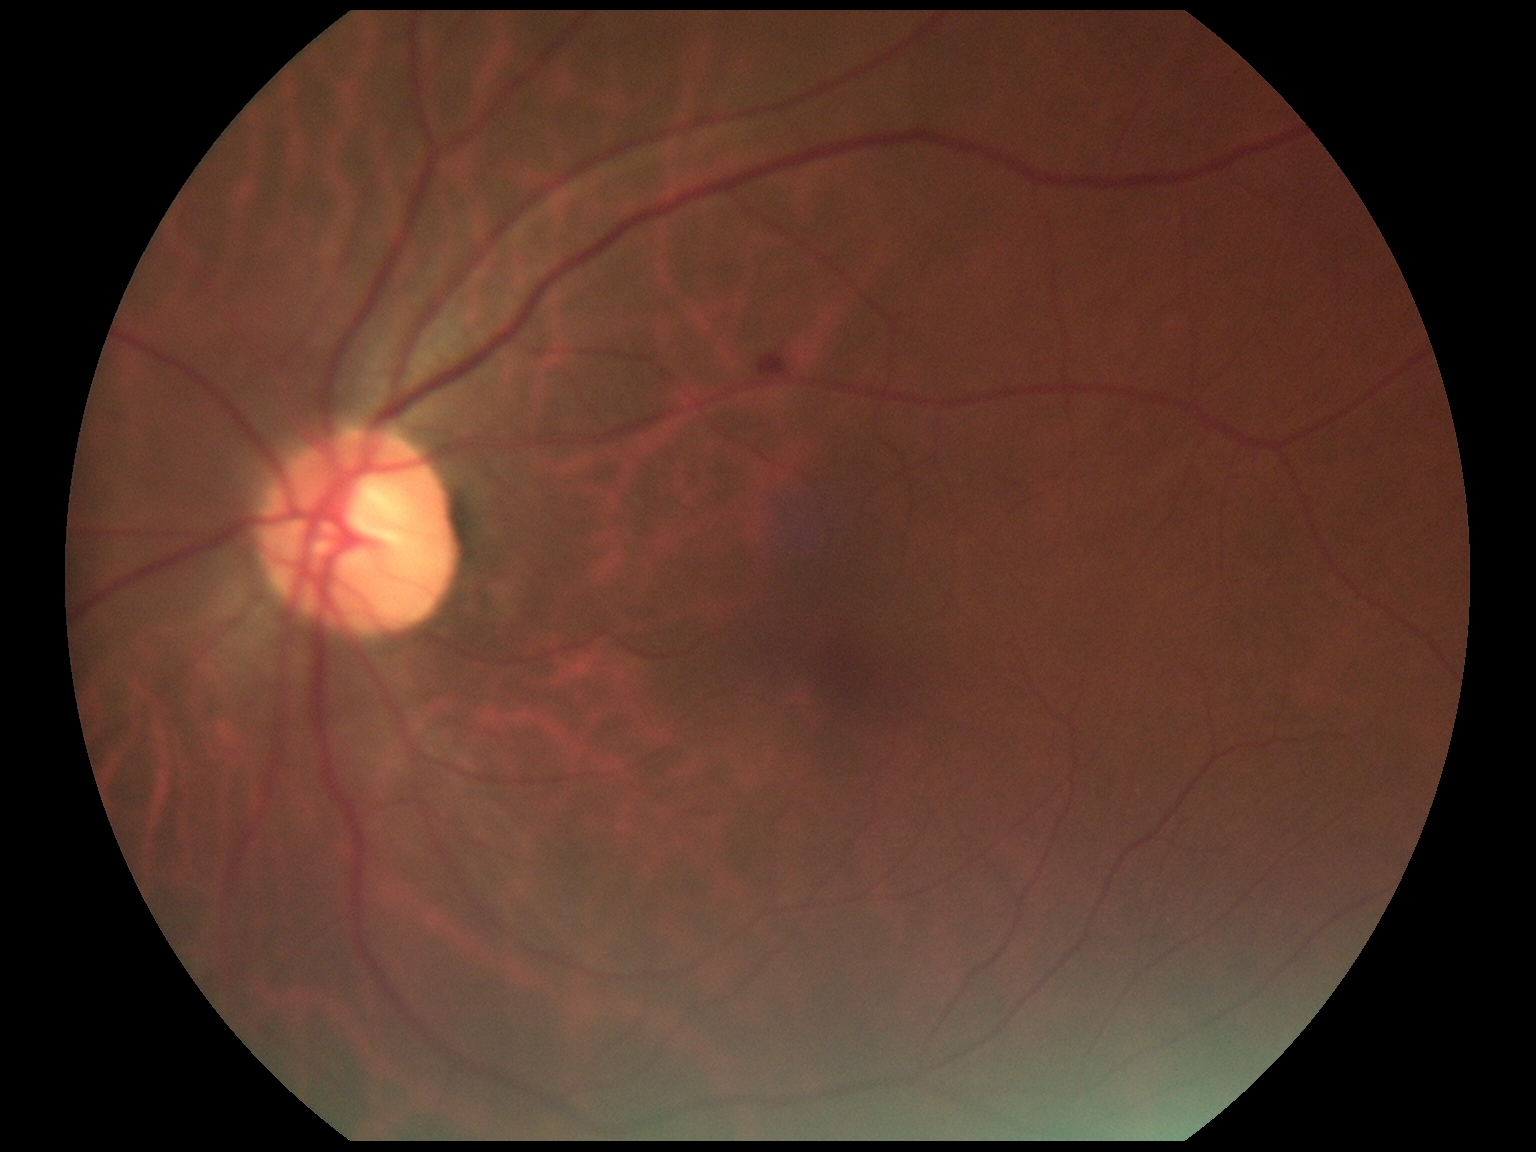 Retinopathy grade is 2.